2352x1568.
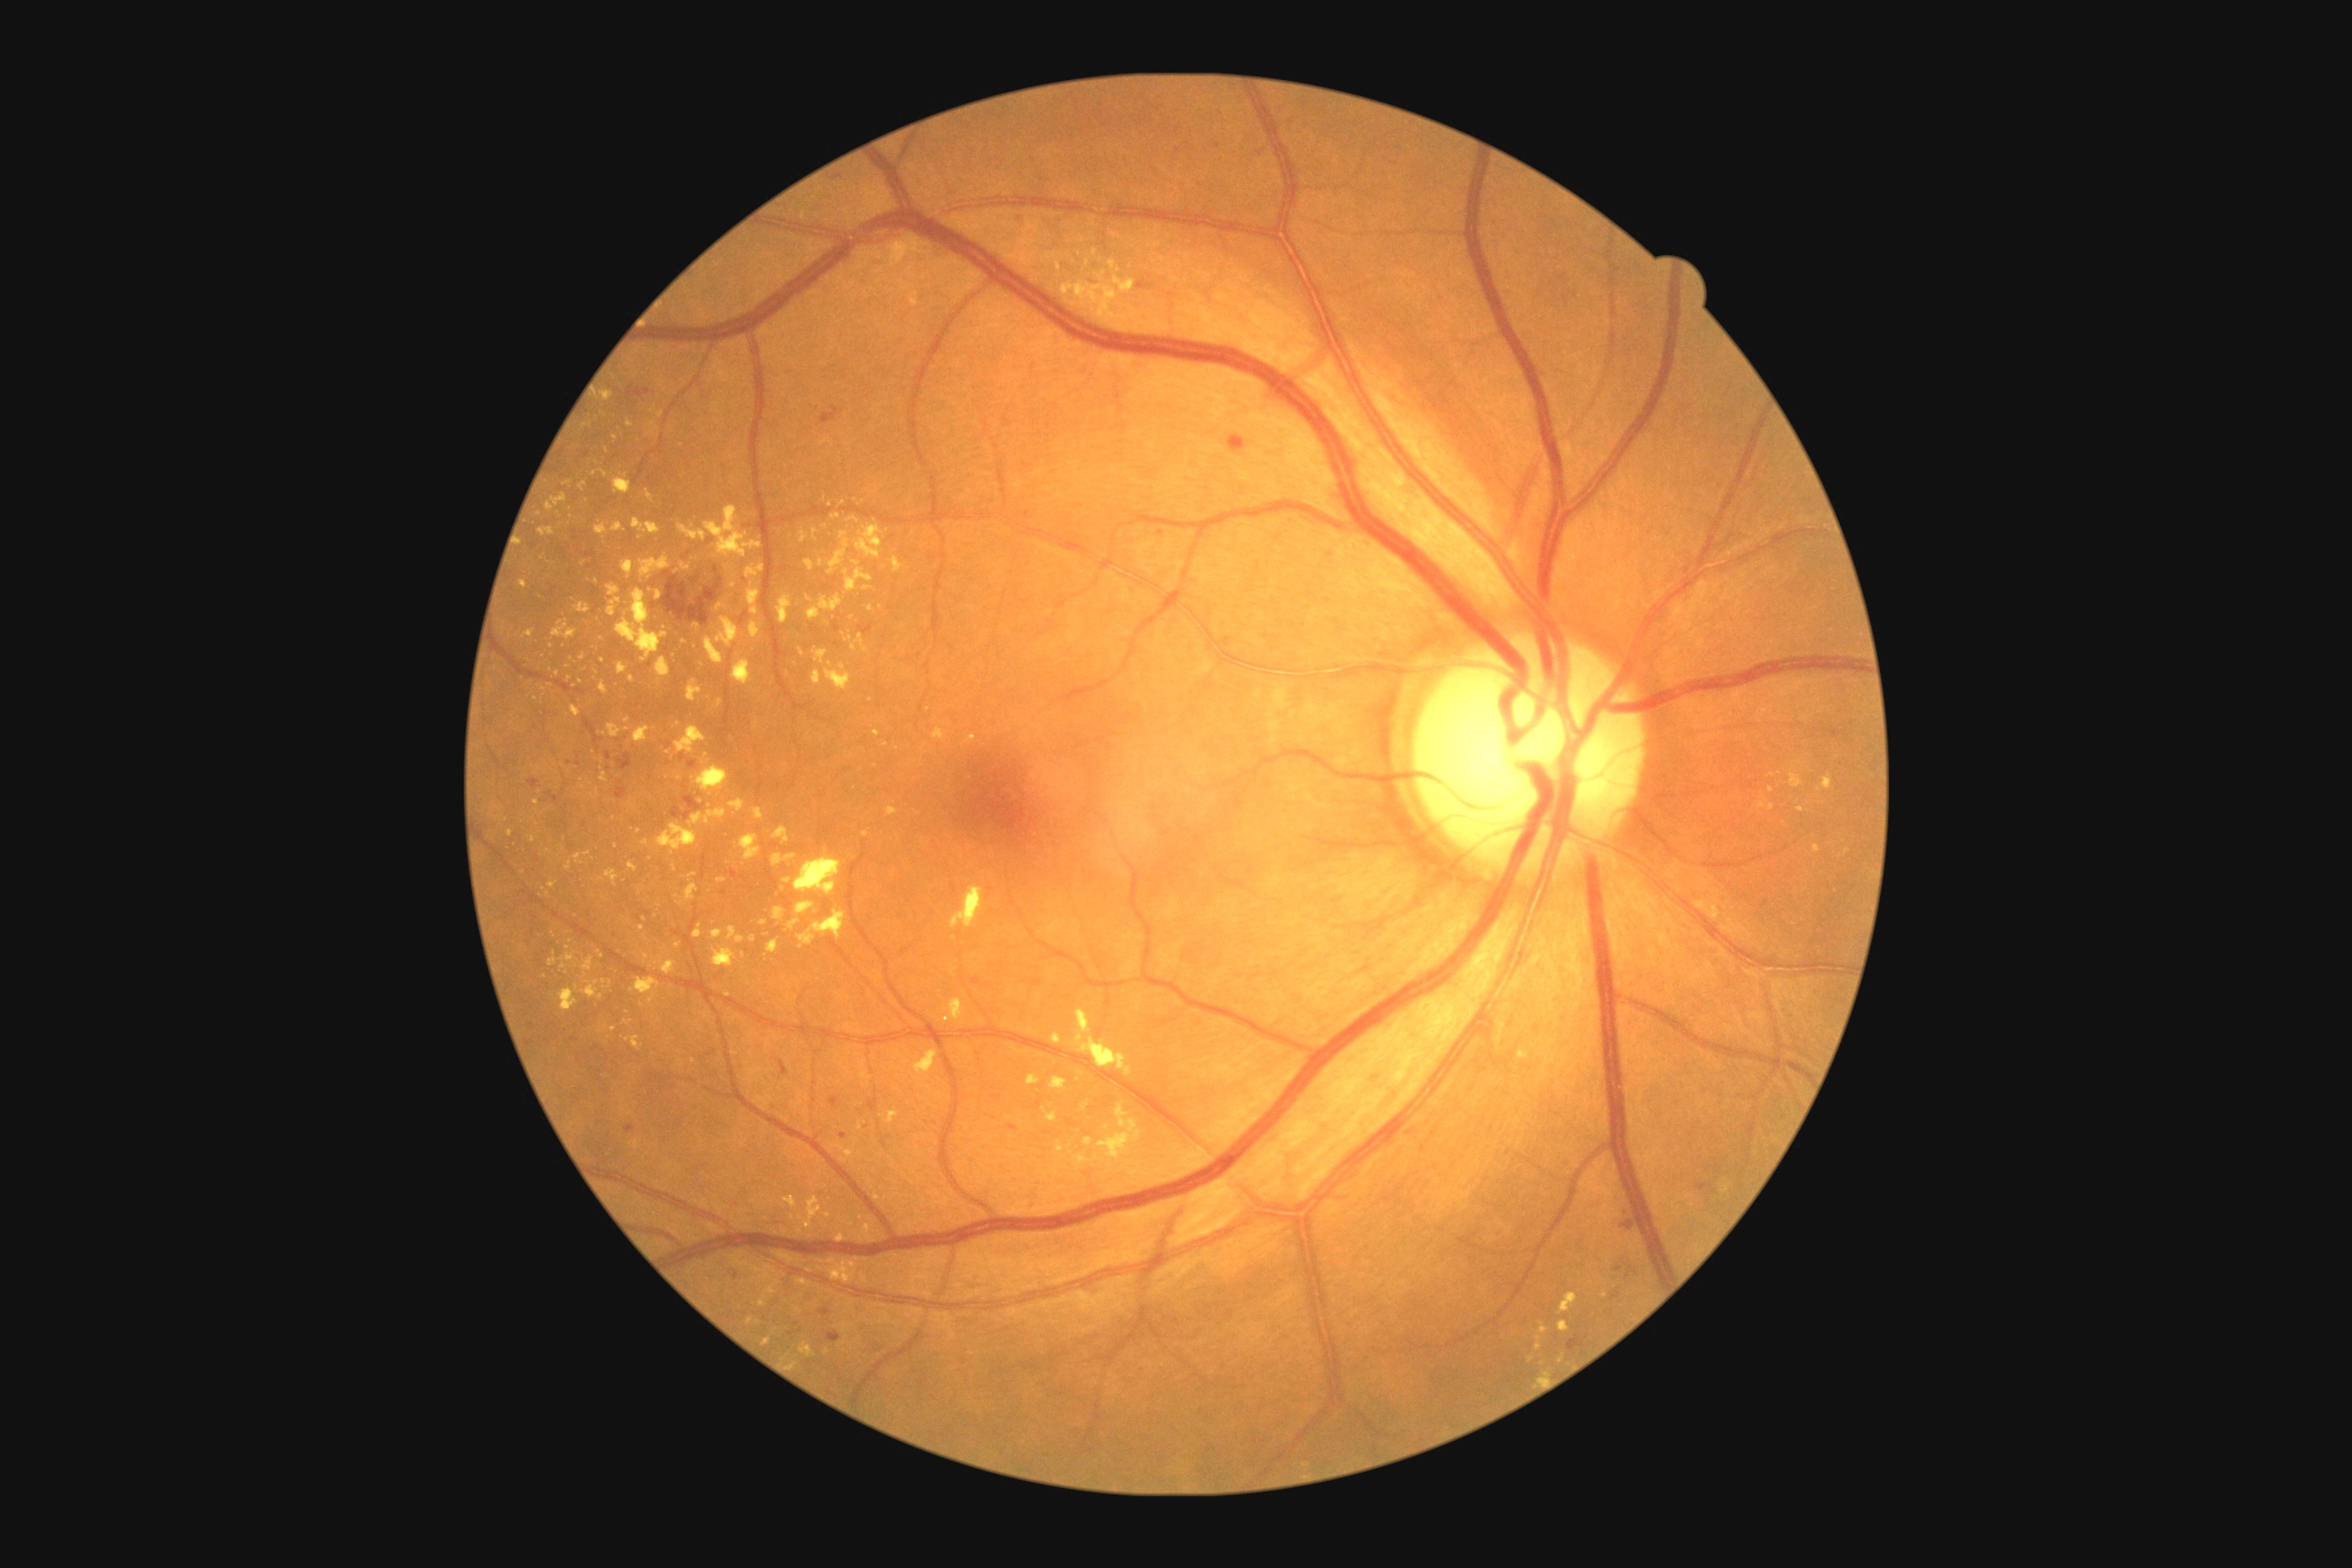
<lesions partial="true">
  <dr_grade>2</dr_grade>
  <se />
  <he partial="true">(1567,1337,1585,1351) | (1614,1266,1623,1273) | (821,406,839,424) | (660,576,725,627) | (1137,282,1152,289) | (868,1097,879,1112) | (1612,1291,1622,1300) | (547,792,558,803) | (859,625,874,634) | (828,1097,839,1108) | (827,1333,843,1342) | (691,578,700,585)</he>
  <he_small>(545,803)</he_small>
  <ex partial="true">(948,997,965,1024) | (863,585,874,591) | (1084,1137,1092,1148) | (612,524,627,533) | (1110,231,1117,239) | (778,1251,796,1264) | (887,1112,899,1124) | (1070,1102,1142,1179) | (852,634,868,652) | (631,977,660,1004) | (701,1010,712,1019)</ex>
  <ex_small>(558,674) | (641,929) | (693,1061) | (800,1217) | (1801,809) | (852,618) | (669,754) | (821,563)</ex_small>
  <ma partial="true">(625,1124,634,1133) | (631,387,636,398) | (972,979,981,986) | (1215,142,1220,150) | (832,1097,836,1108) | (607,752,612,761) | (689,761,696,769)</ma>
  <ma_small>(724,893) | (669,745) | (747,581) | (609,768) | (1027,516)</ma_small>
</lesions>